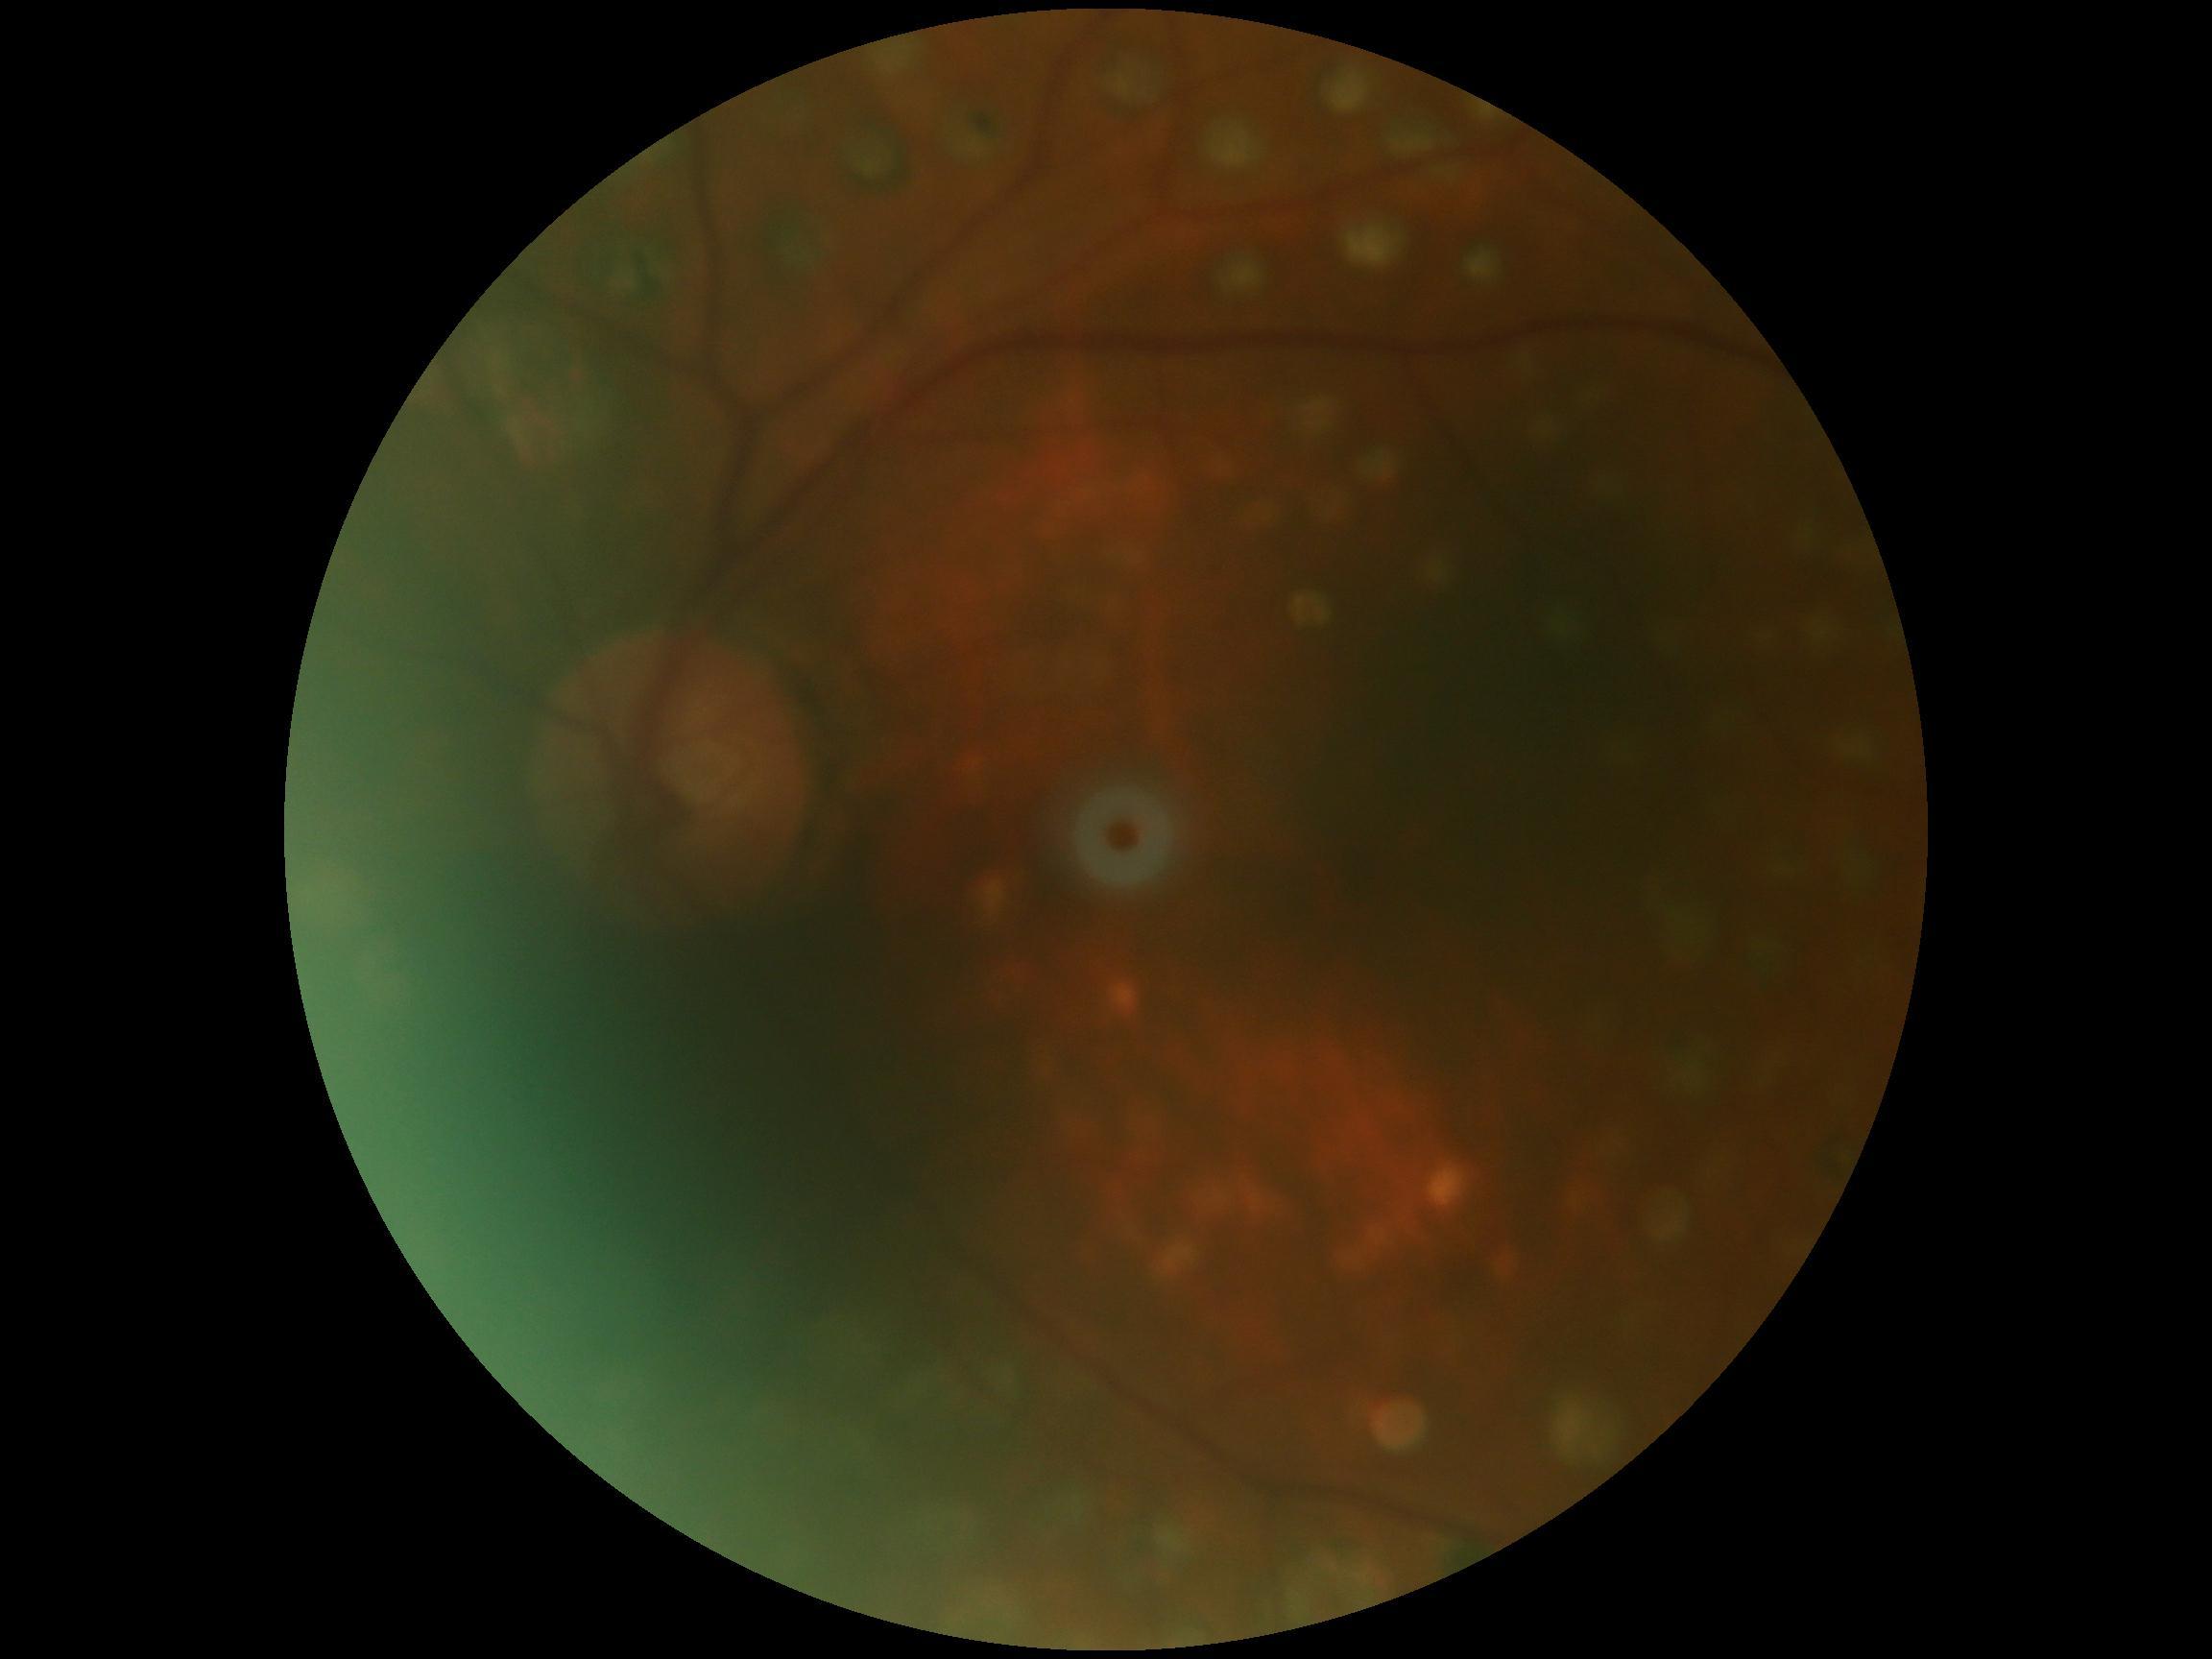 Diabetic retinopathy (DR): grade 0 (no apparent retinopathy).